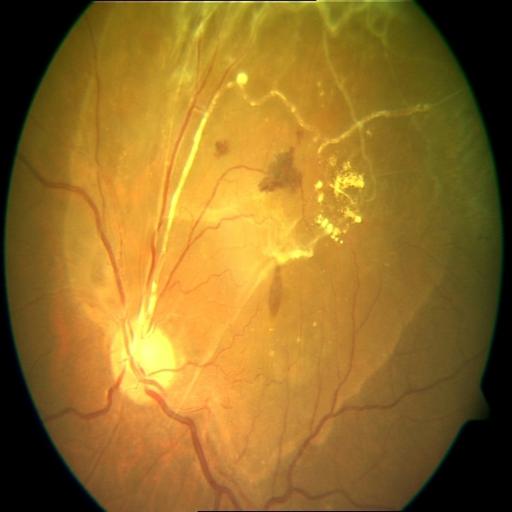 3 findings. Fundus image with findings of HR (hemorrhagic retinopathy), VS (vasculitis) and RT (retinal traction).